Retinal fundus photograph · 45-degree field of view · 2352x1568px.
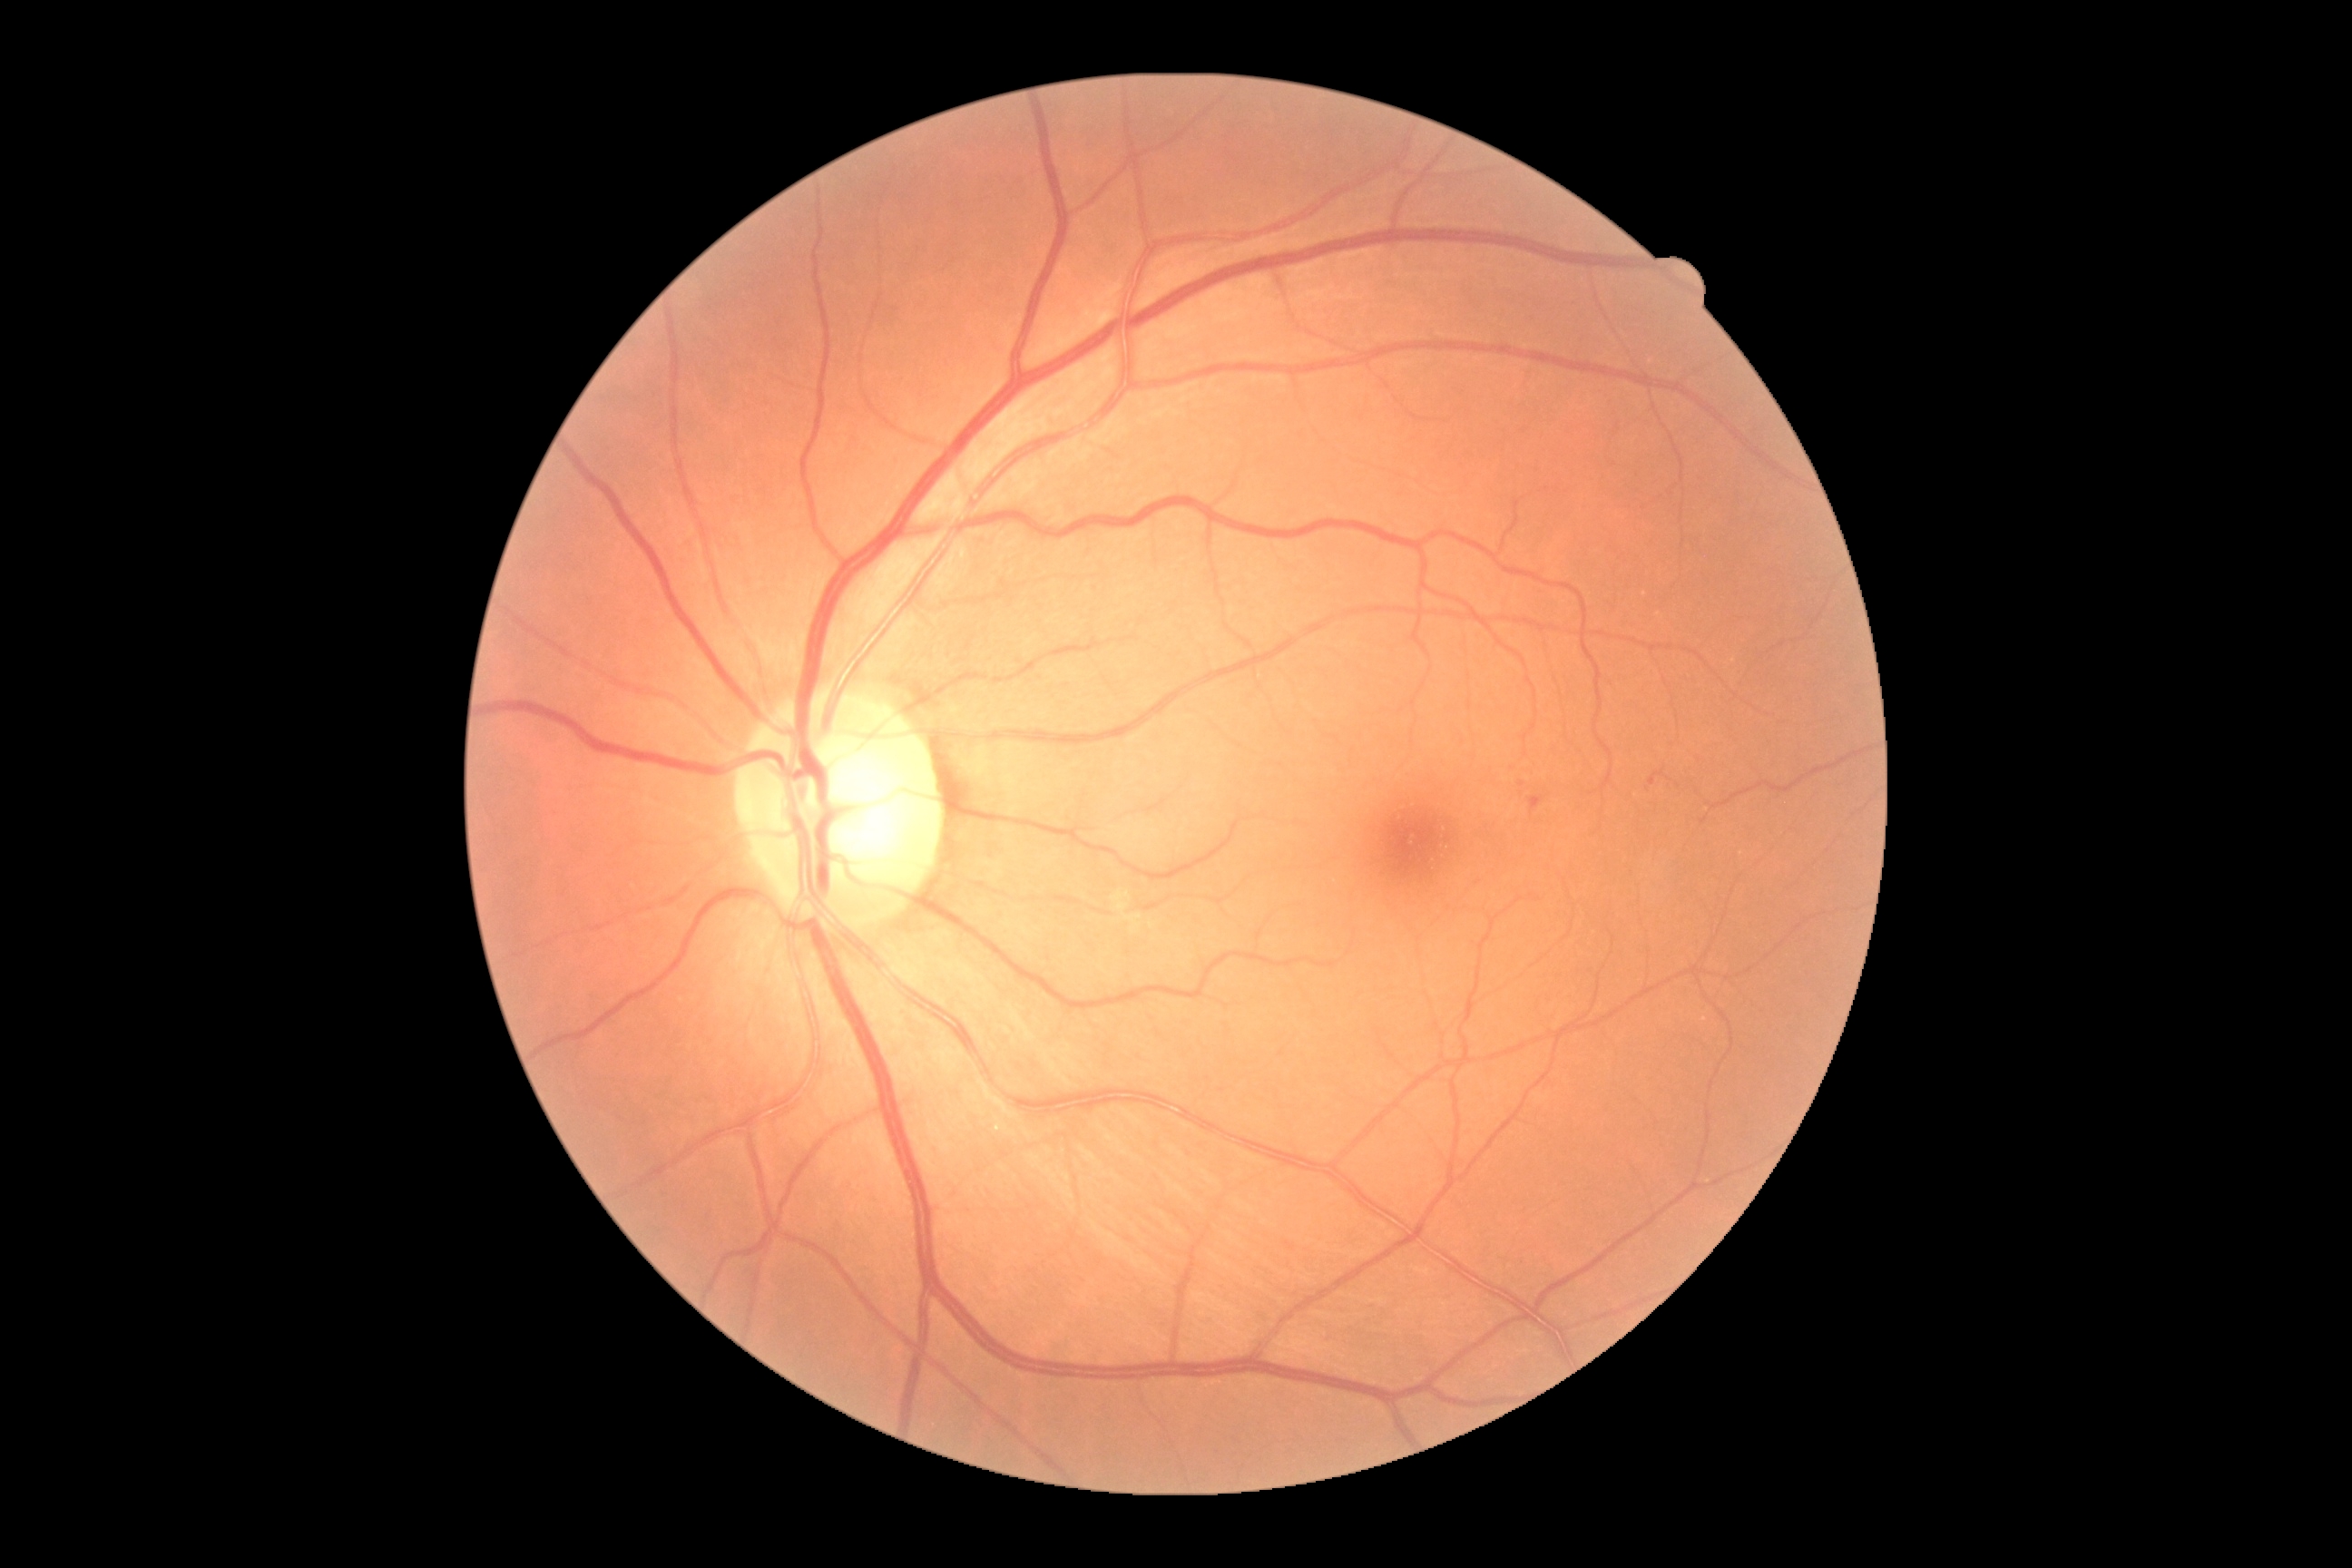
{
  "dr_grade": "grade 1 (mild NPDR)"
}